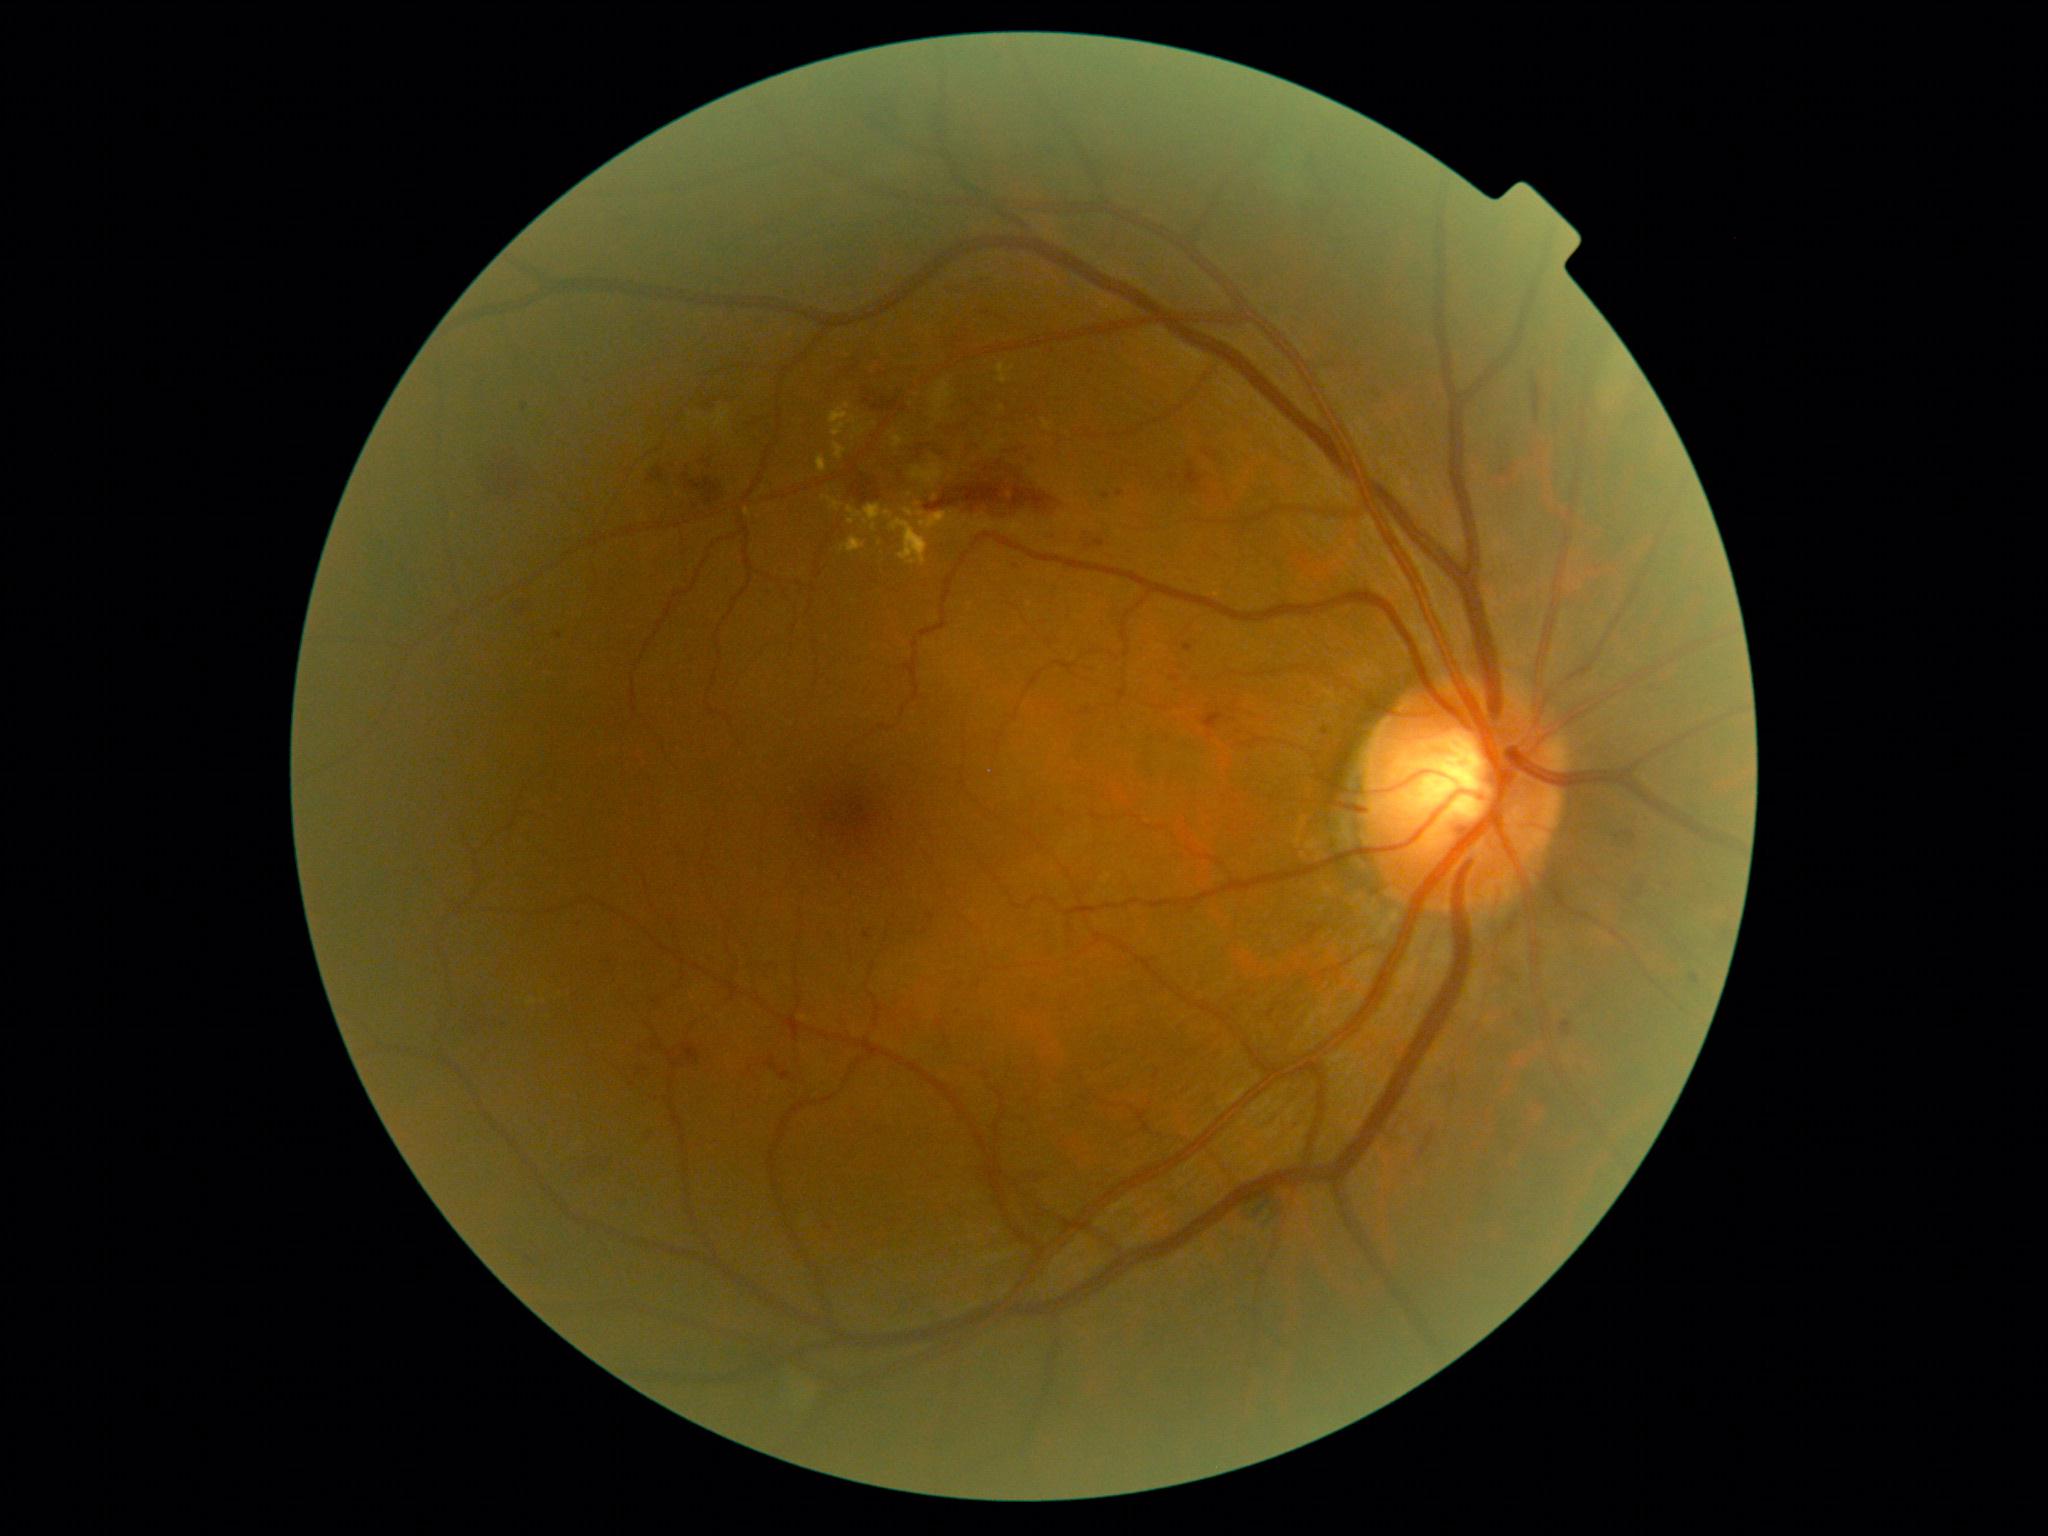 DR class = non-proliferative diabetic retinopathy | retinopathy grade = moderate NPDR (2).